Color fundus photograph
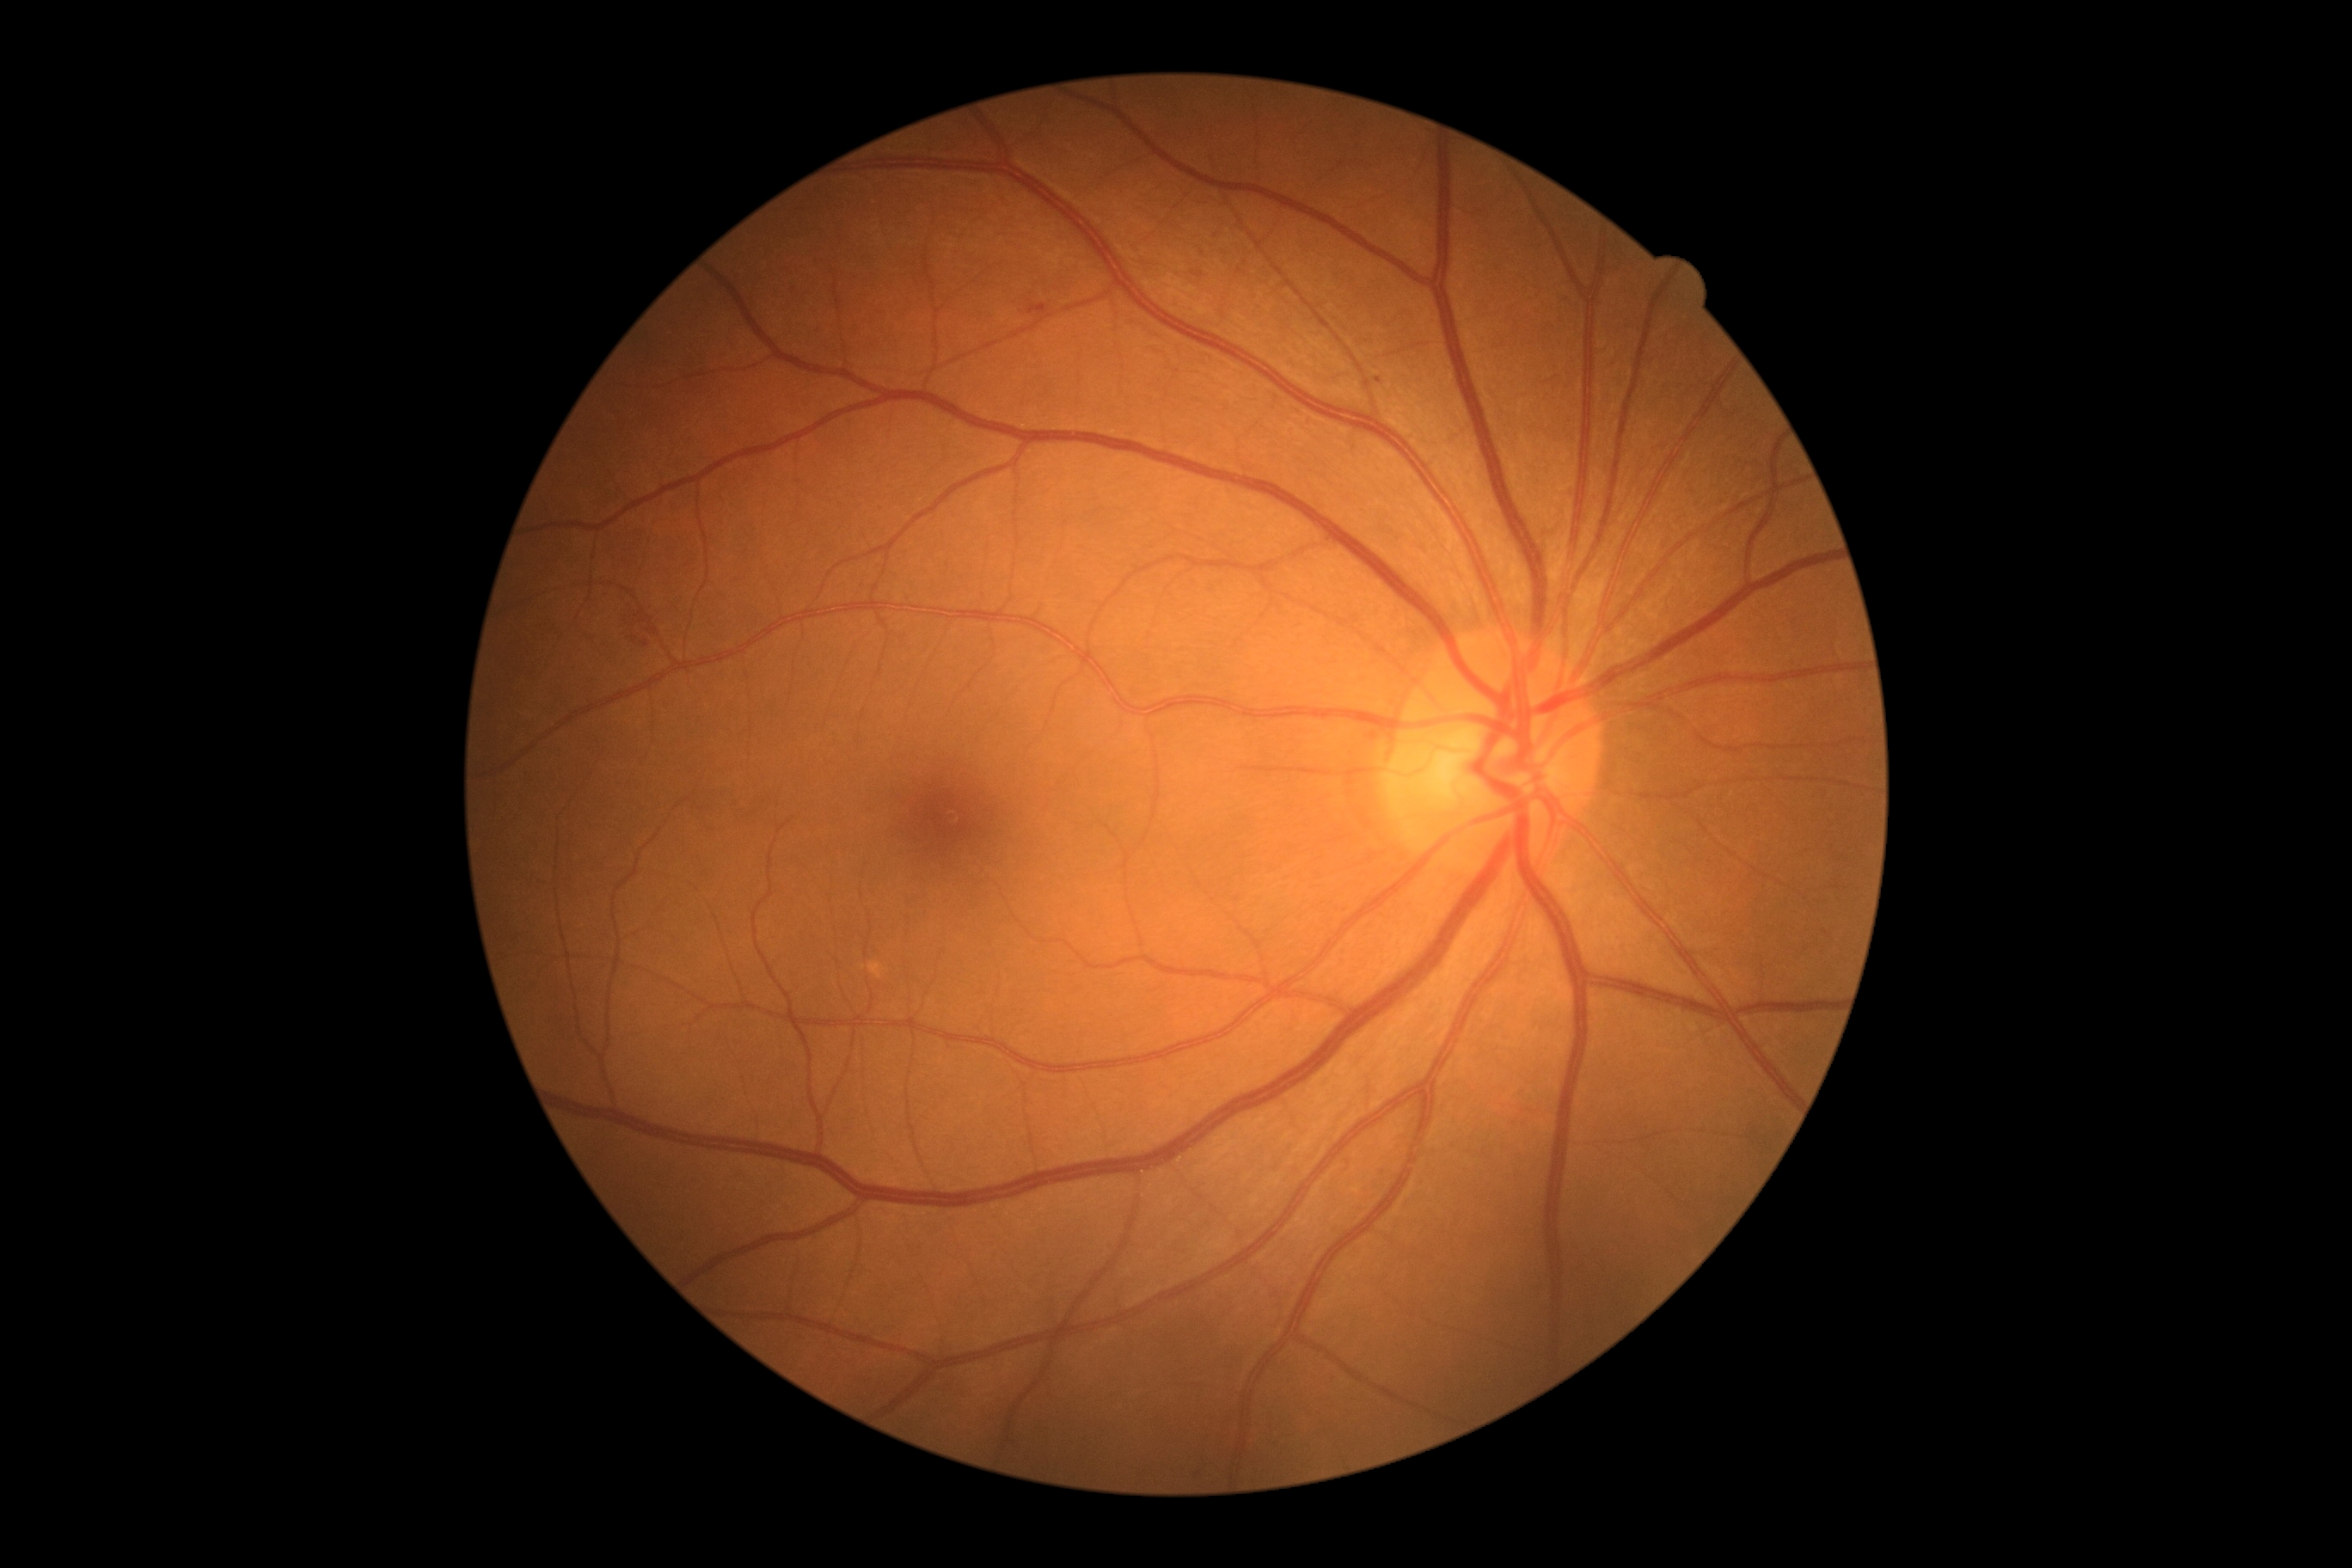
Findings:
– retinopathy grade — 2